Diabetic retinopathy graded by the modified Davis classification, 45-degree field of view, NIDEK AFC-230 — 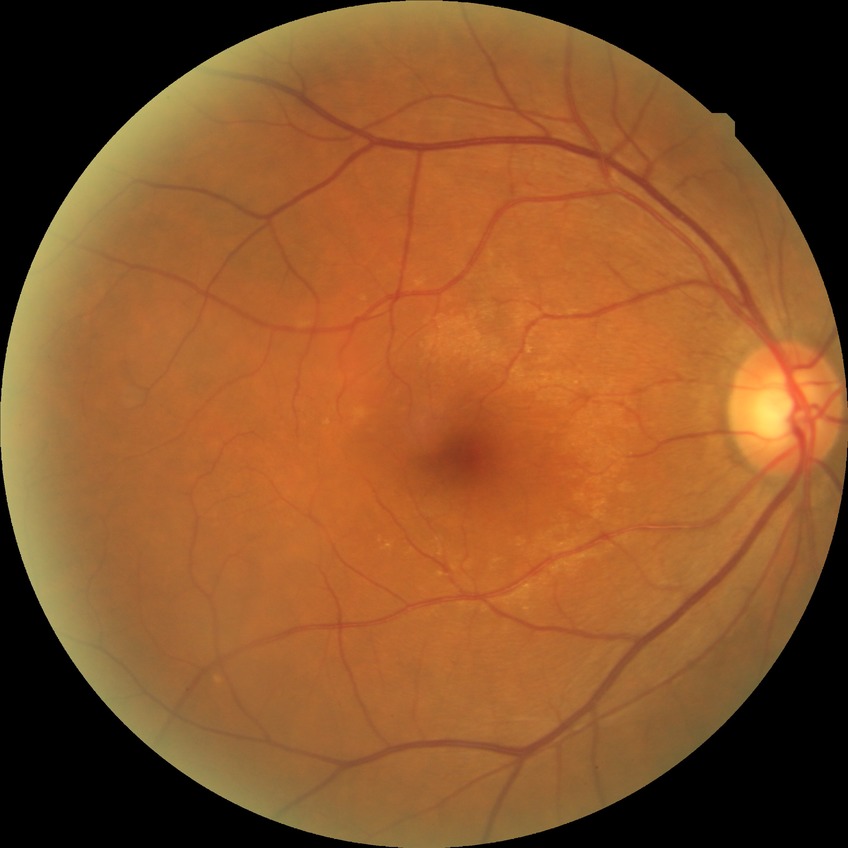 {"davis_grade": "NDR (no diabetic retinopathy)"}